Optic nerve head photograph — 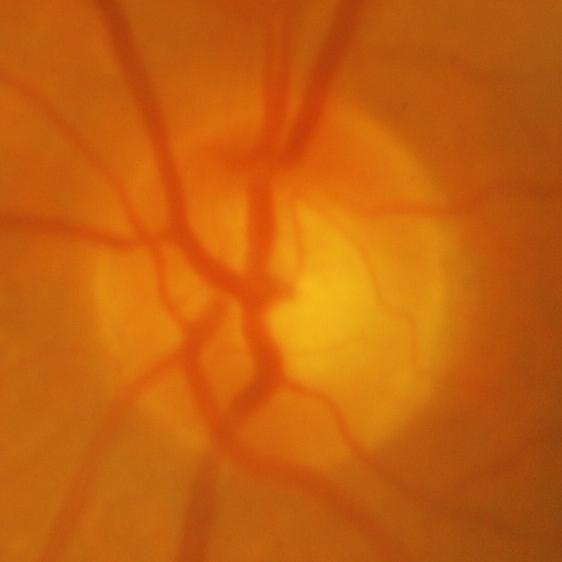 Showing glaucomatous changes.